45-degree field of view
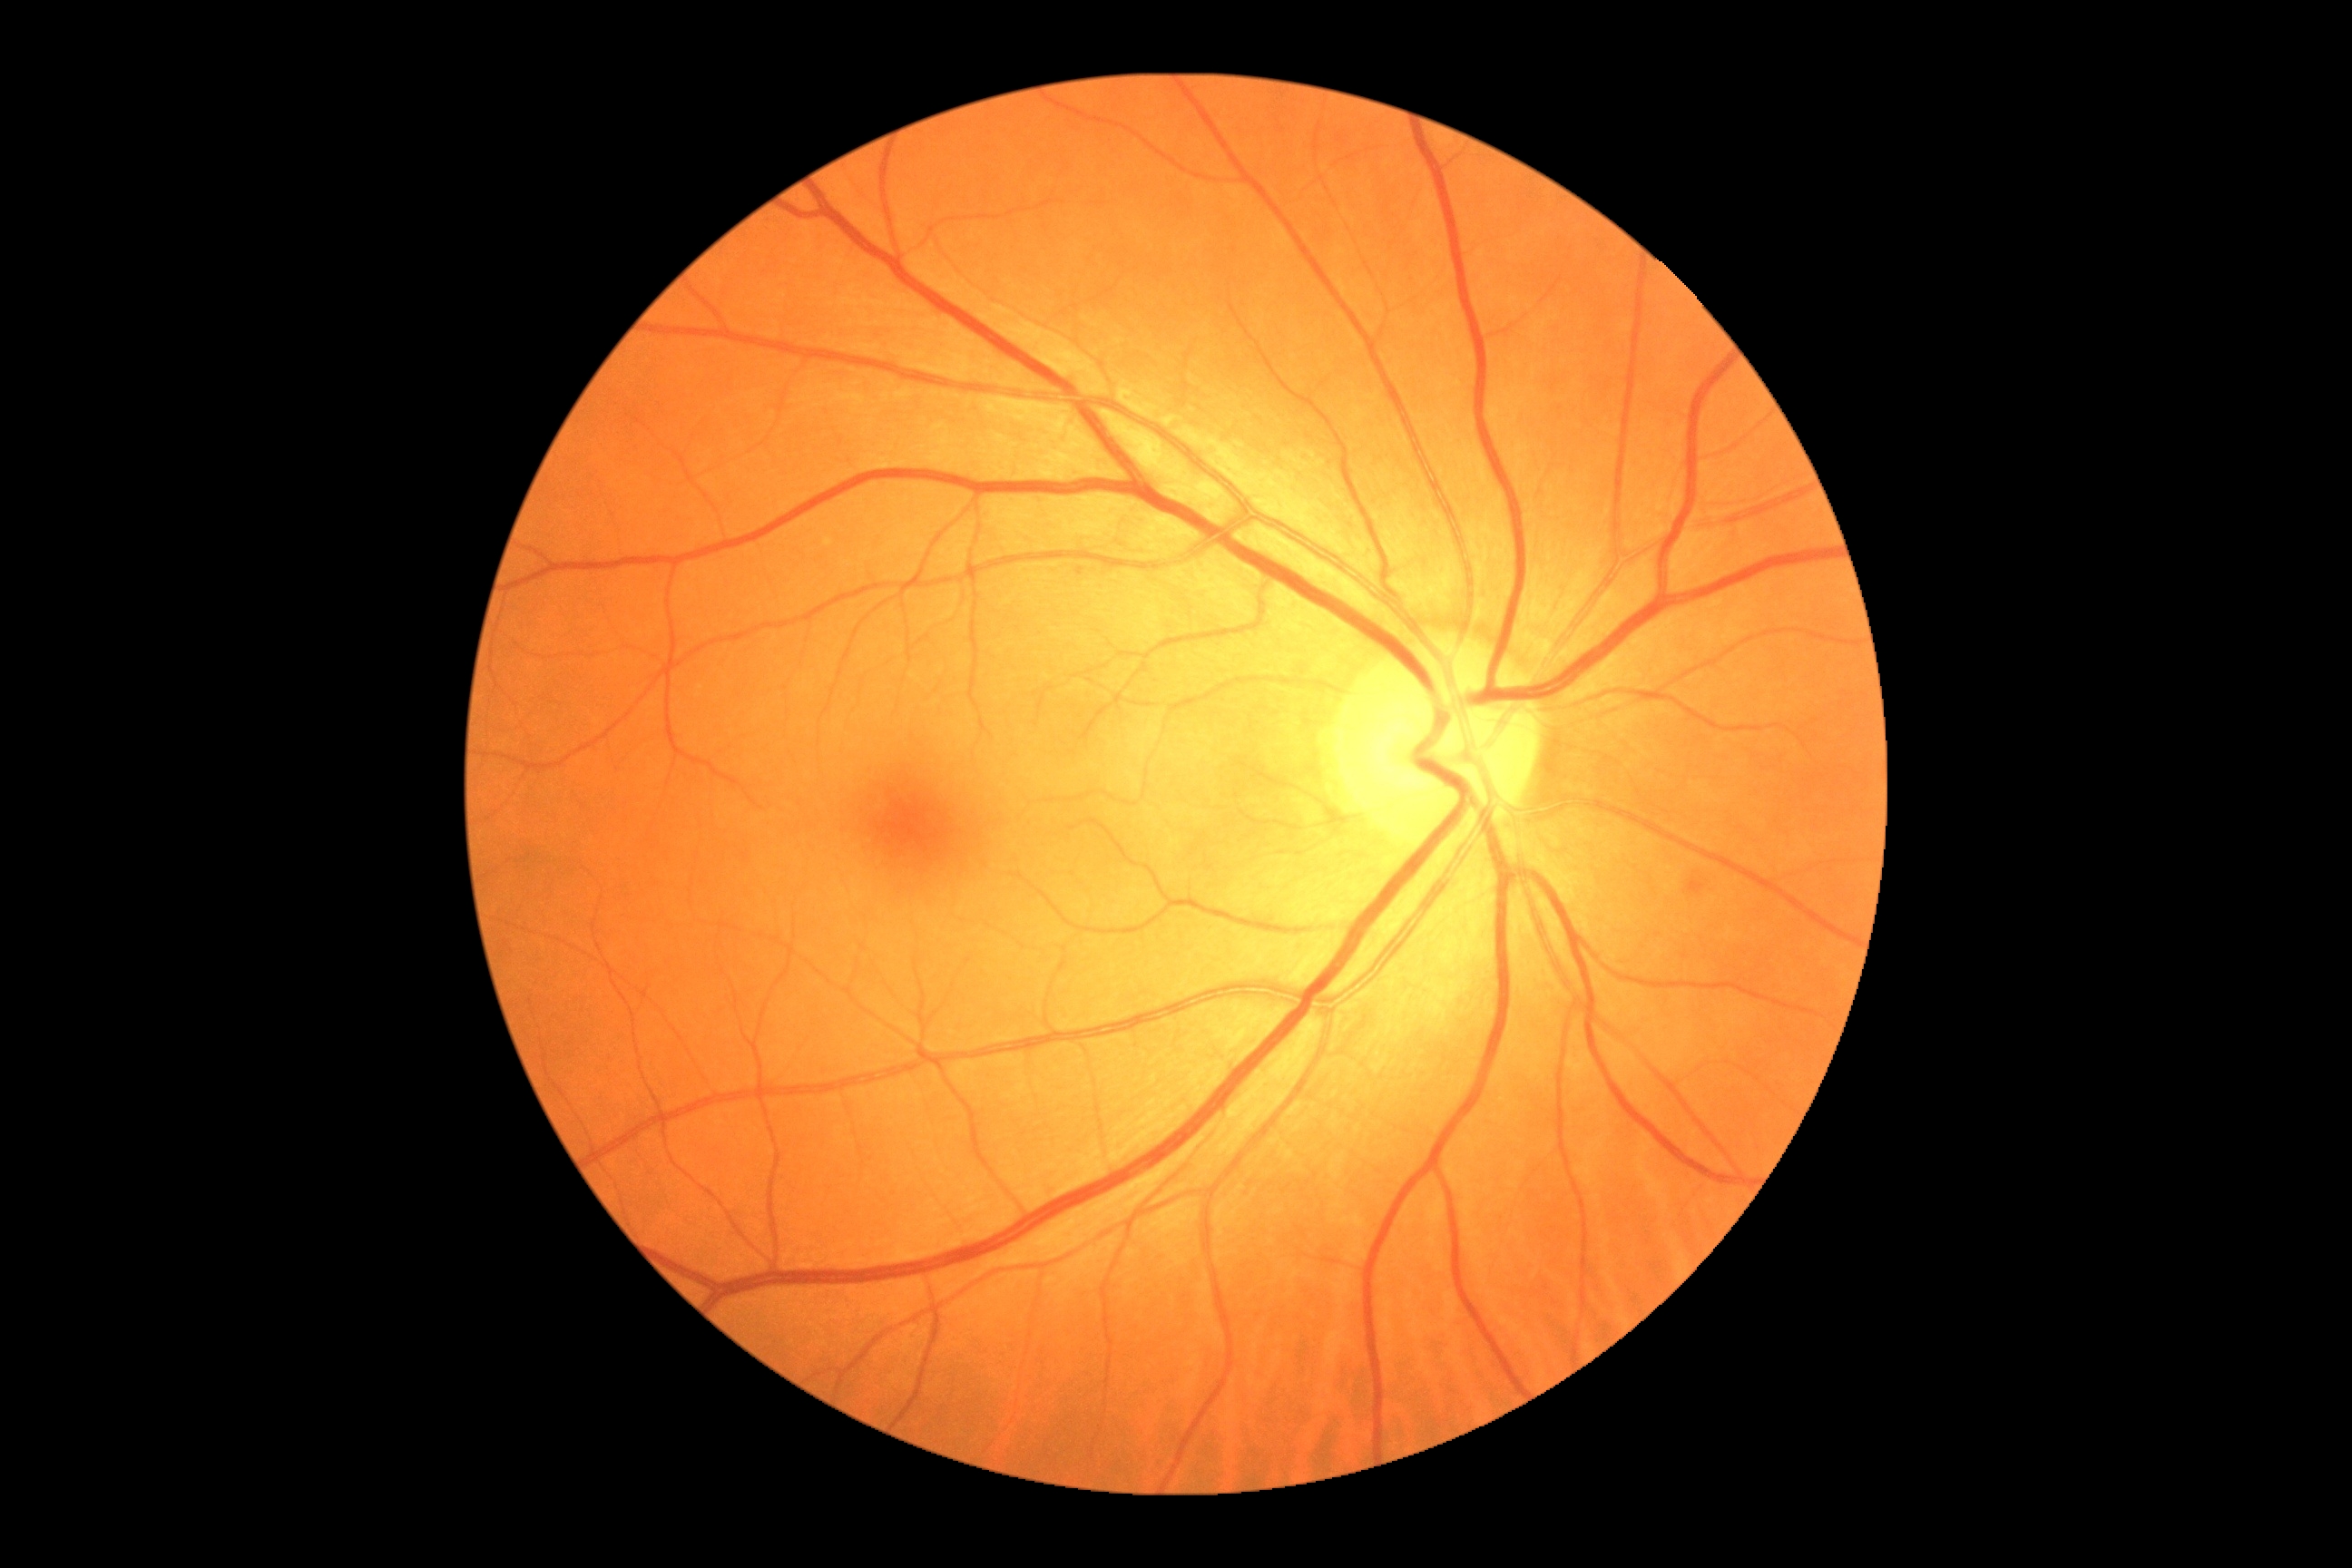   dr_category: non-proliferative diabetic retinopathy
  dr_grade: moderate non-proliferative diabetic retinopathy (grade 2)